NIDEK AFC-230 fundus camera; 45 degree fundus photograph; diabetic retinopathy graded by the modified Davis classification — 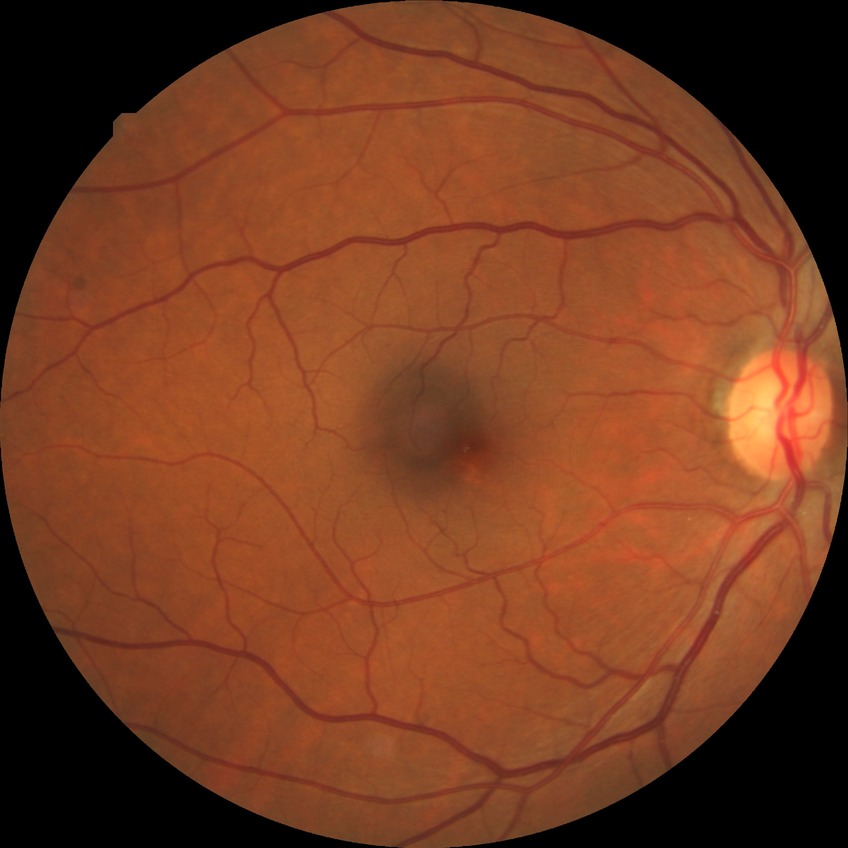
Annotations:
• diabetic retinopathy (DR): NDR (no diabetic retinopathy)